Acquired with a NIDEK AFC-230:
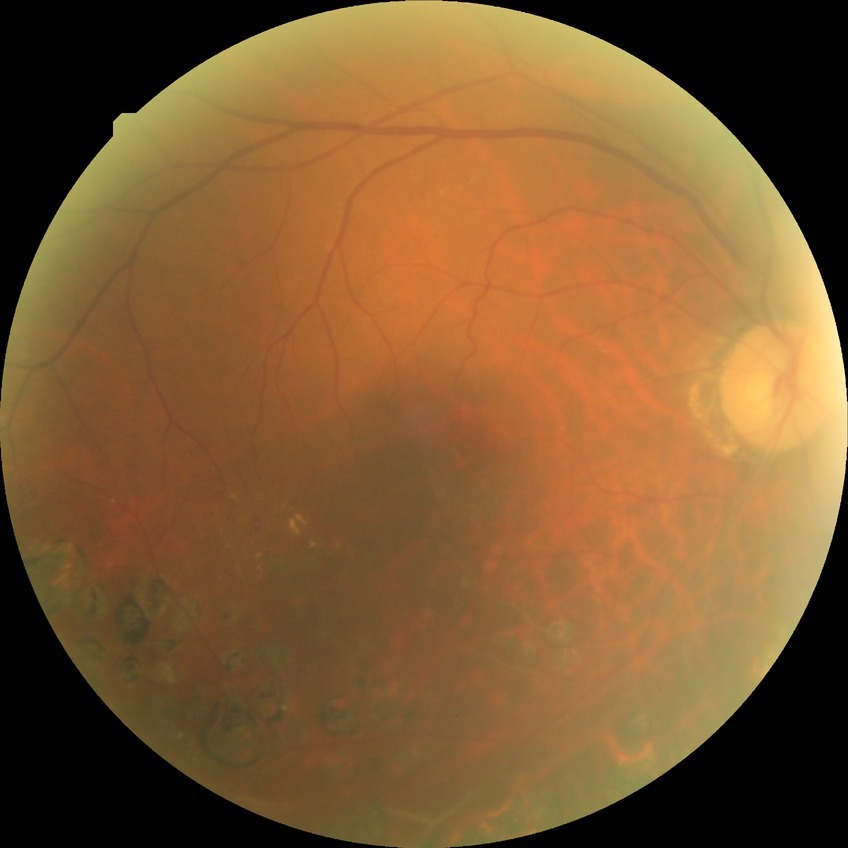

Findings:
* diabetic retinopathy (DR) — no diabetic retinopathy (NDR)